Acquired on the Clarity RetCam 3. Pediatric retinal photograph (wide-field). Image size 640x480 — 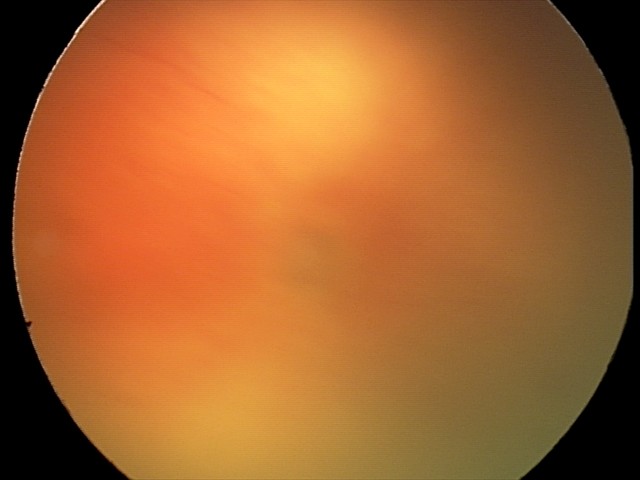 Plus disease was diagnosed.
Examination diagnosed as aggressive ROP (A-ROP).